45-degree field of view; color fundus image
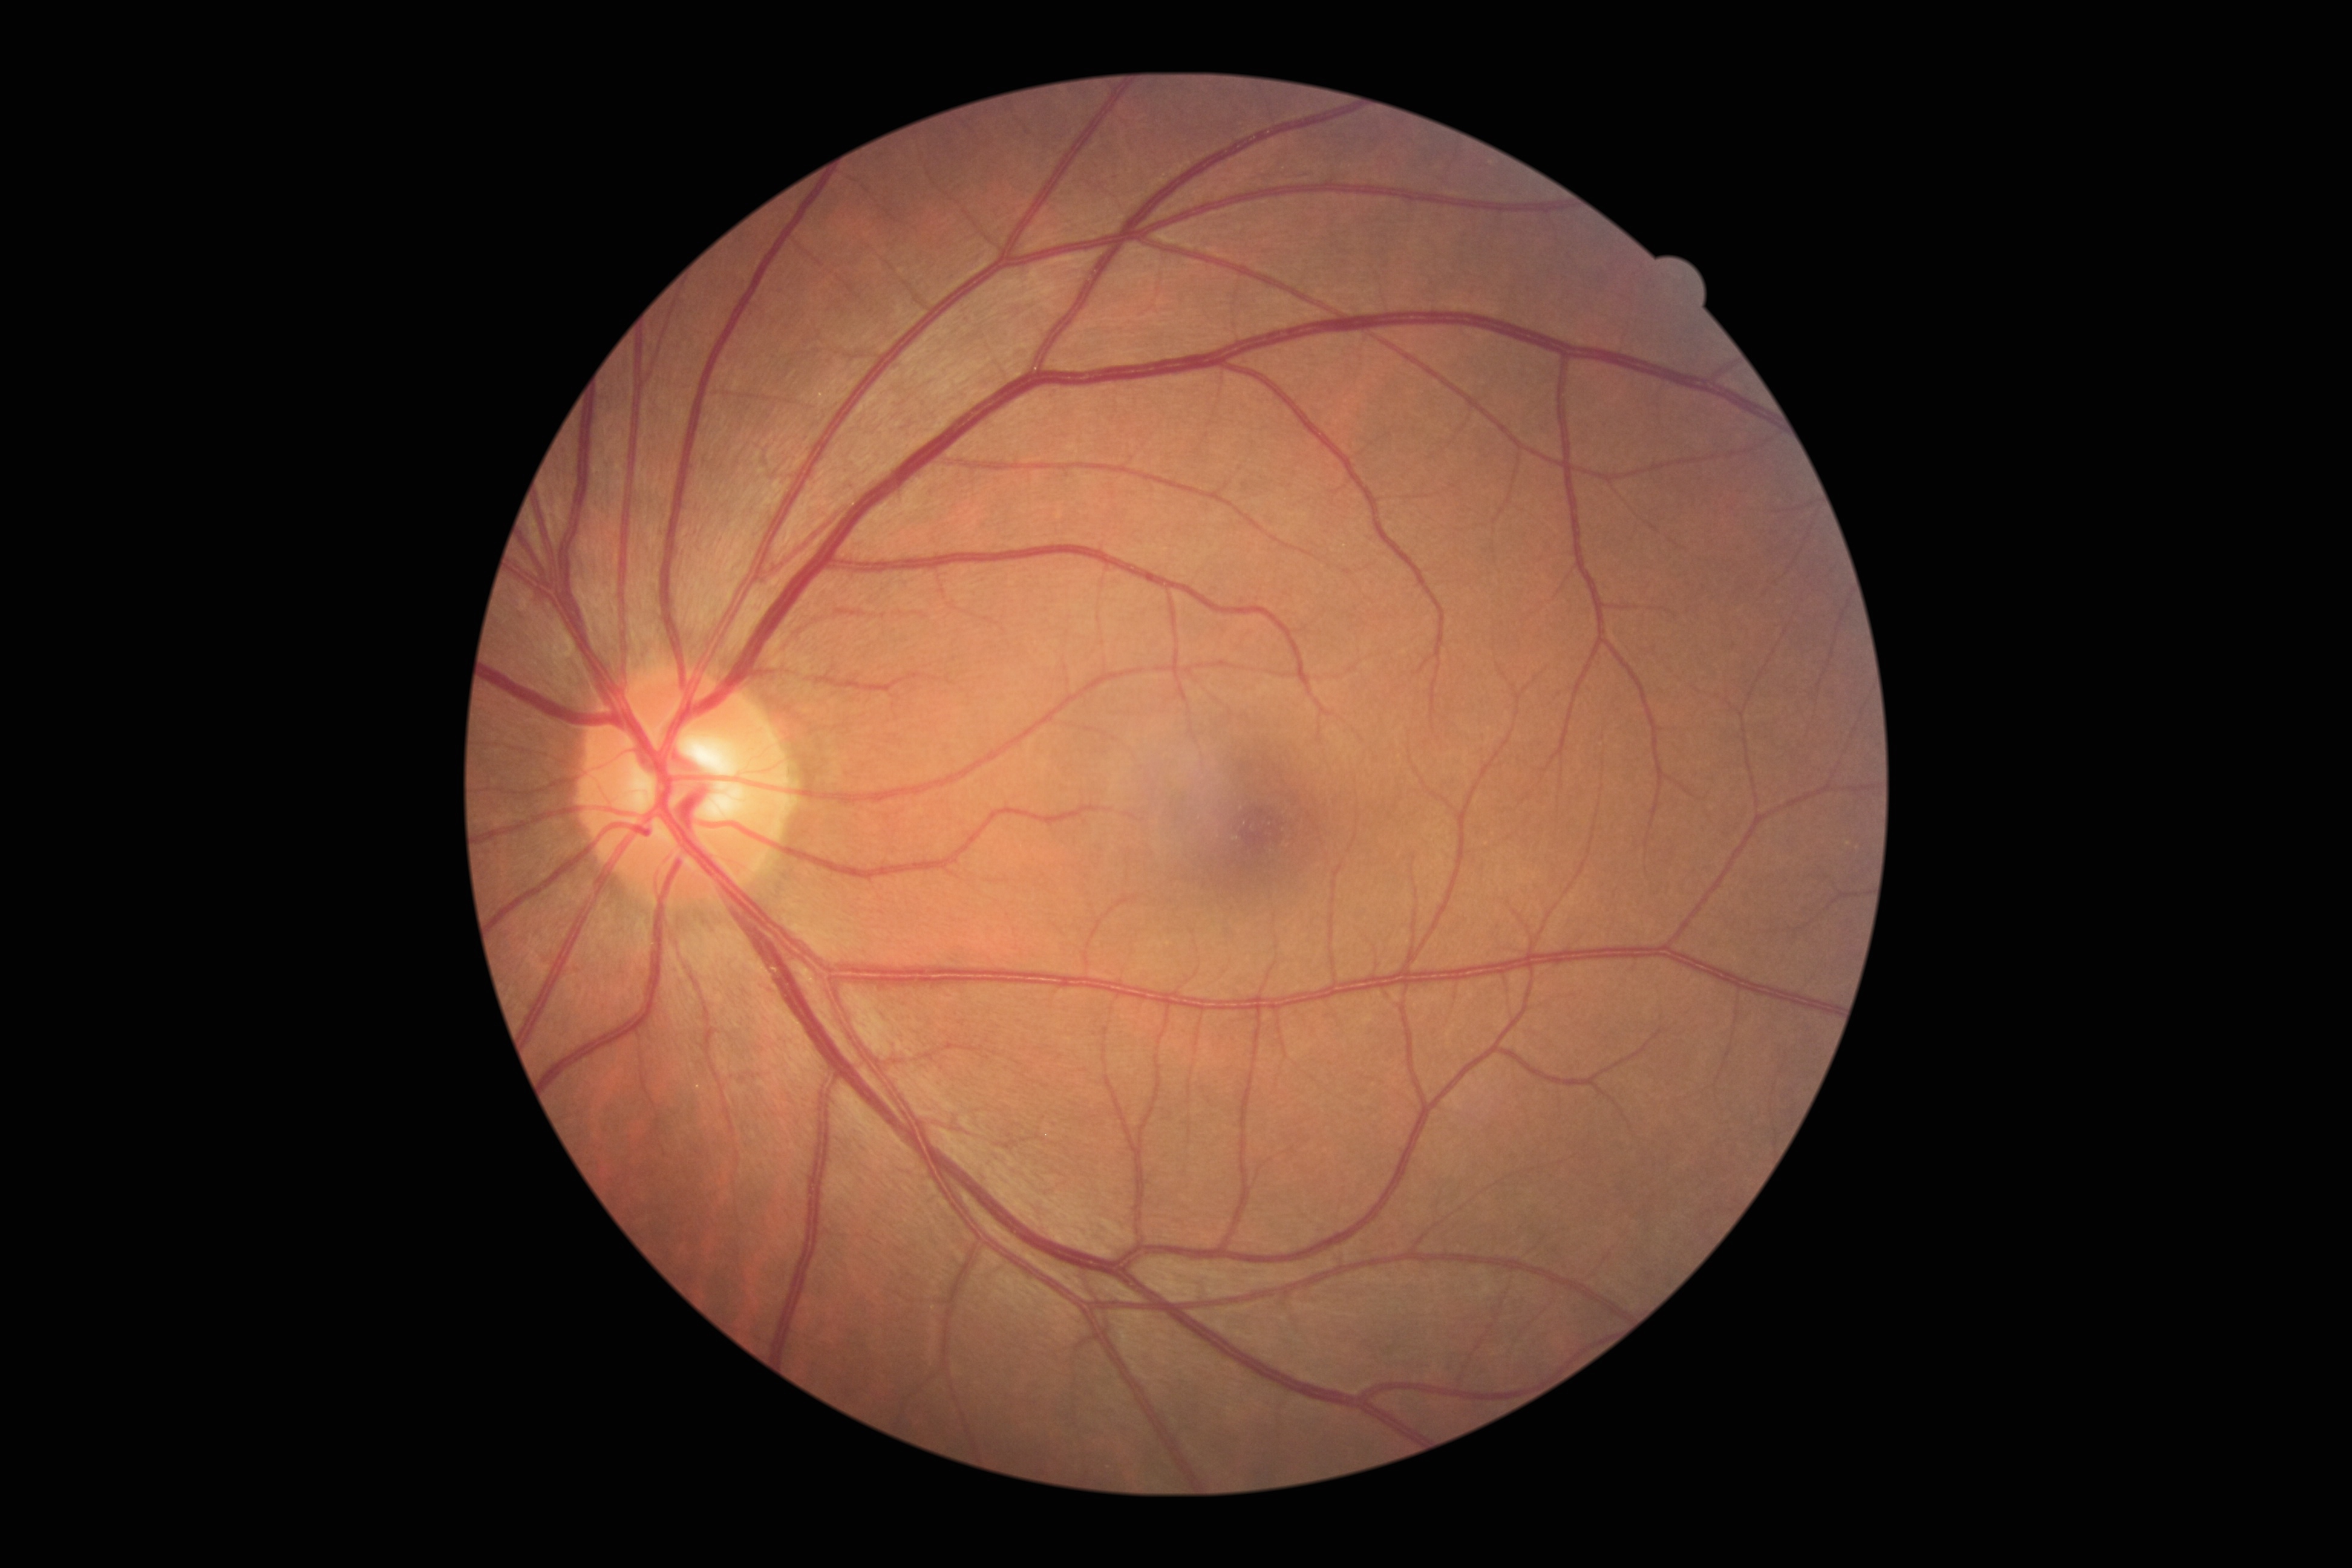

{"dr_grade": "0 — no visible signs of diabetic retinopathy", "dr_impression": "negative for DR"}